Color fundus photograph; 45° field of view; 2048 x 1536 pixels.
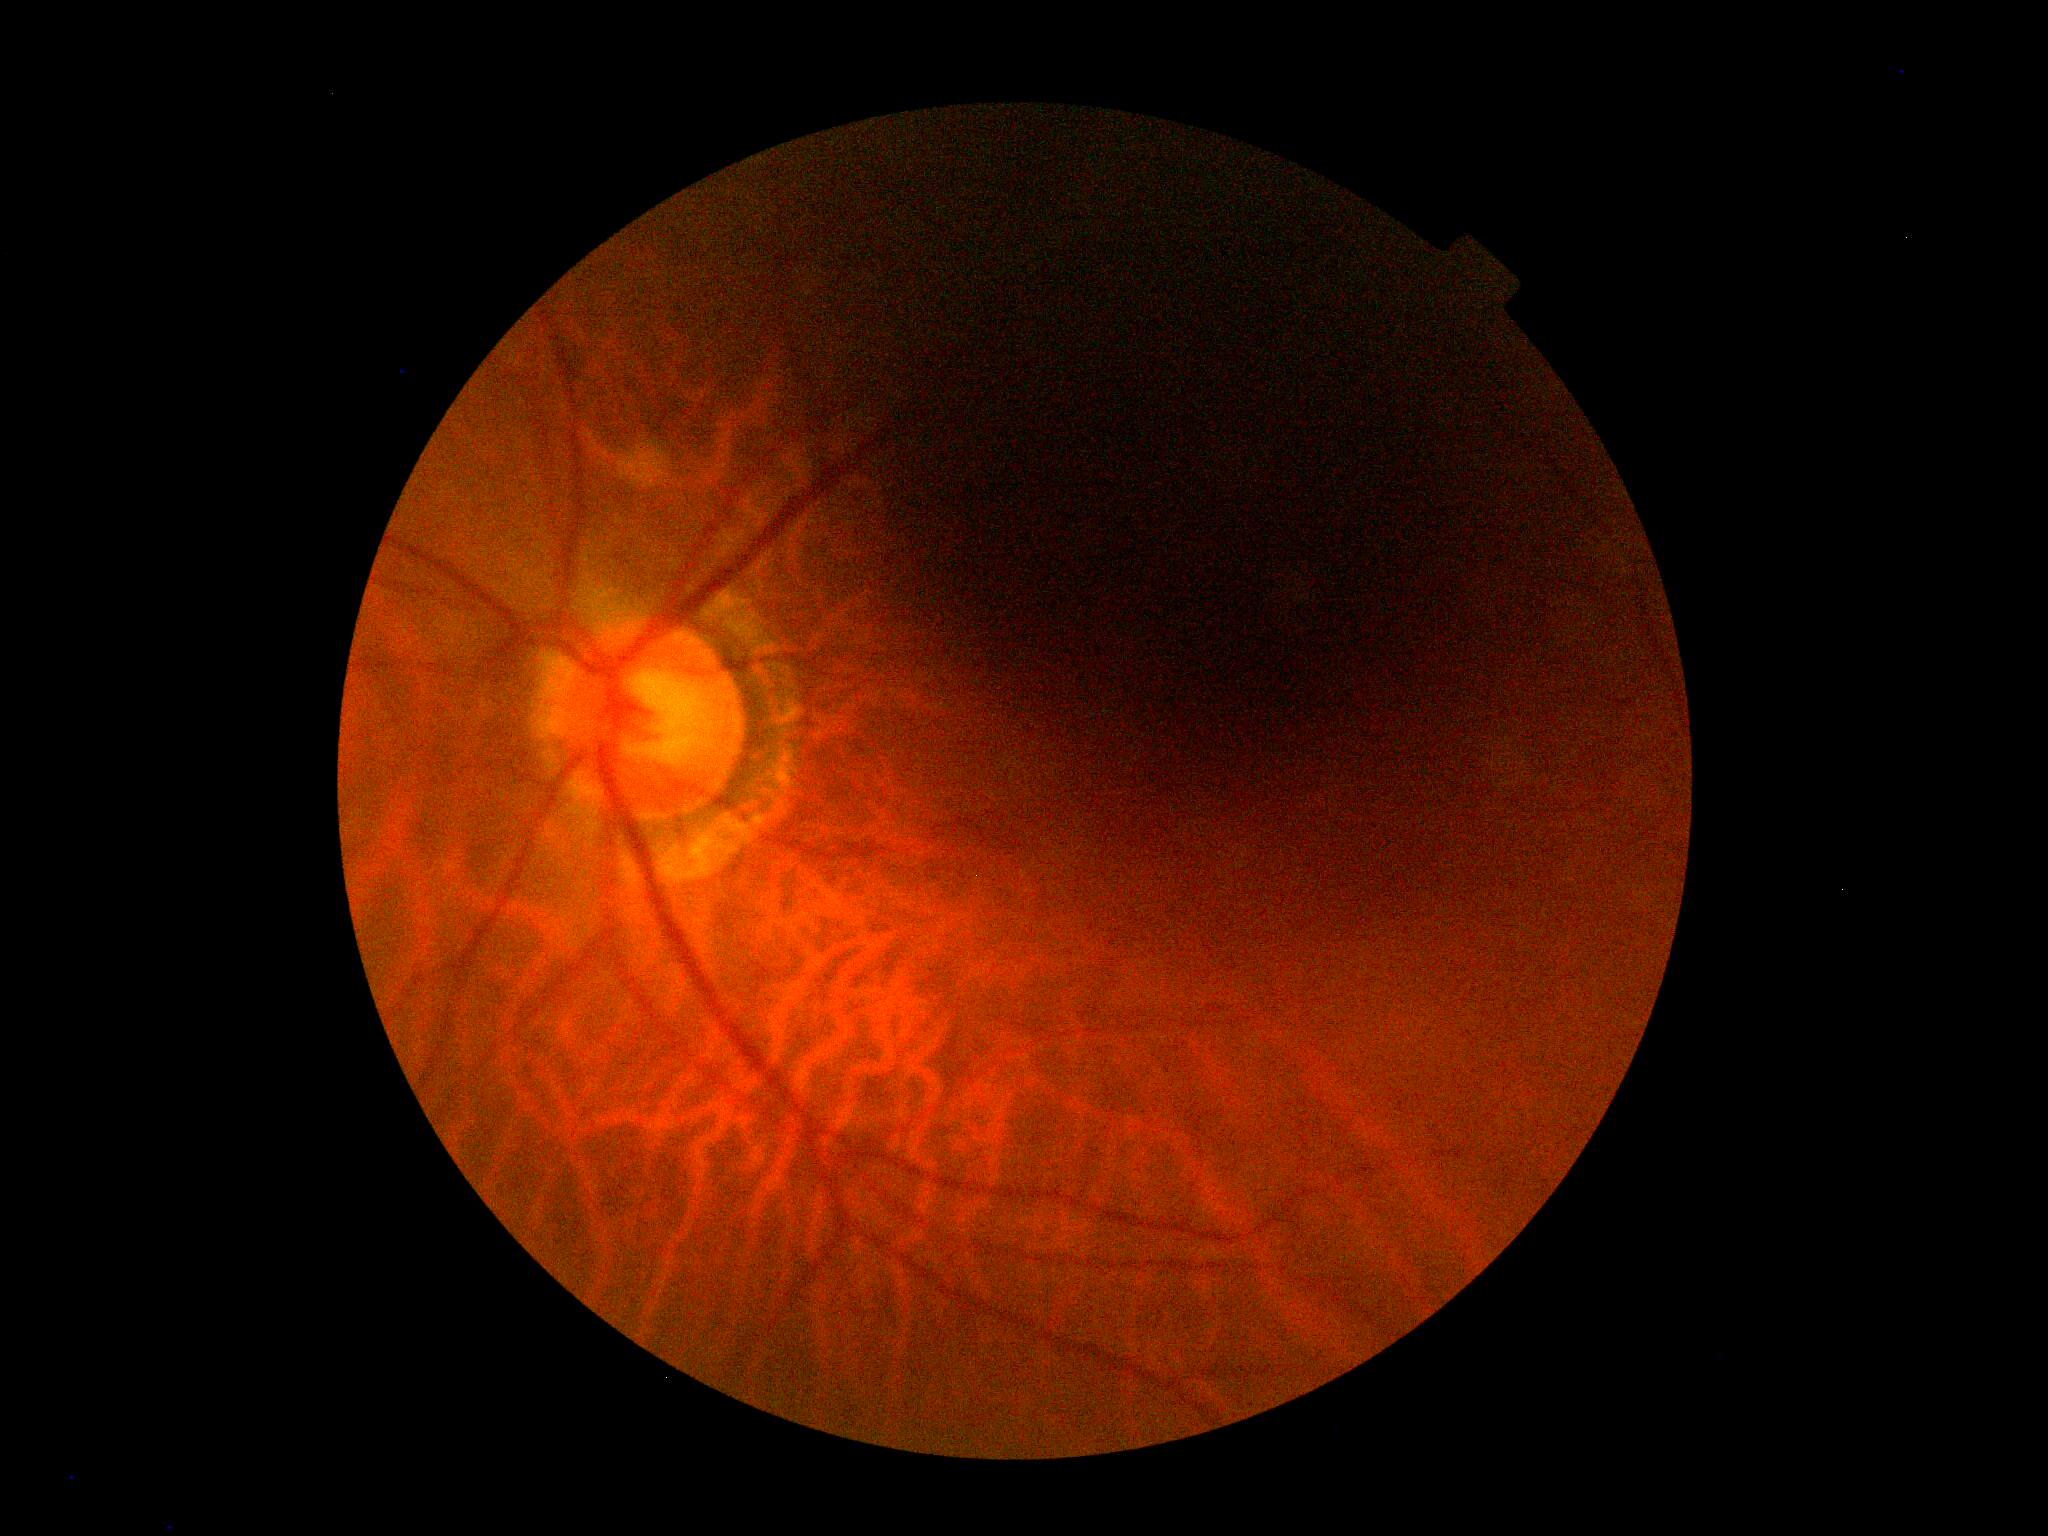

dr_grade: ungradable due to poor image quality
quality: too poor for DR grading